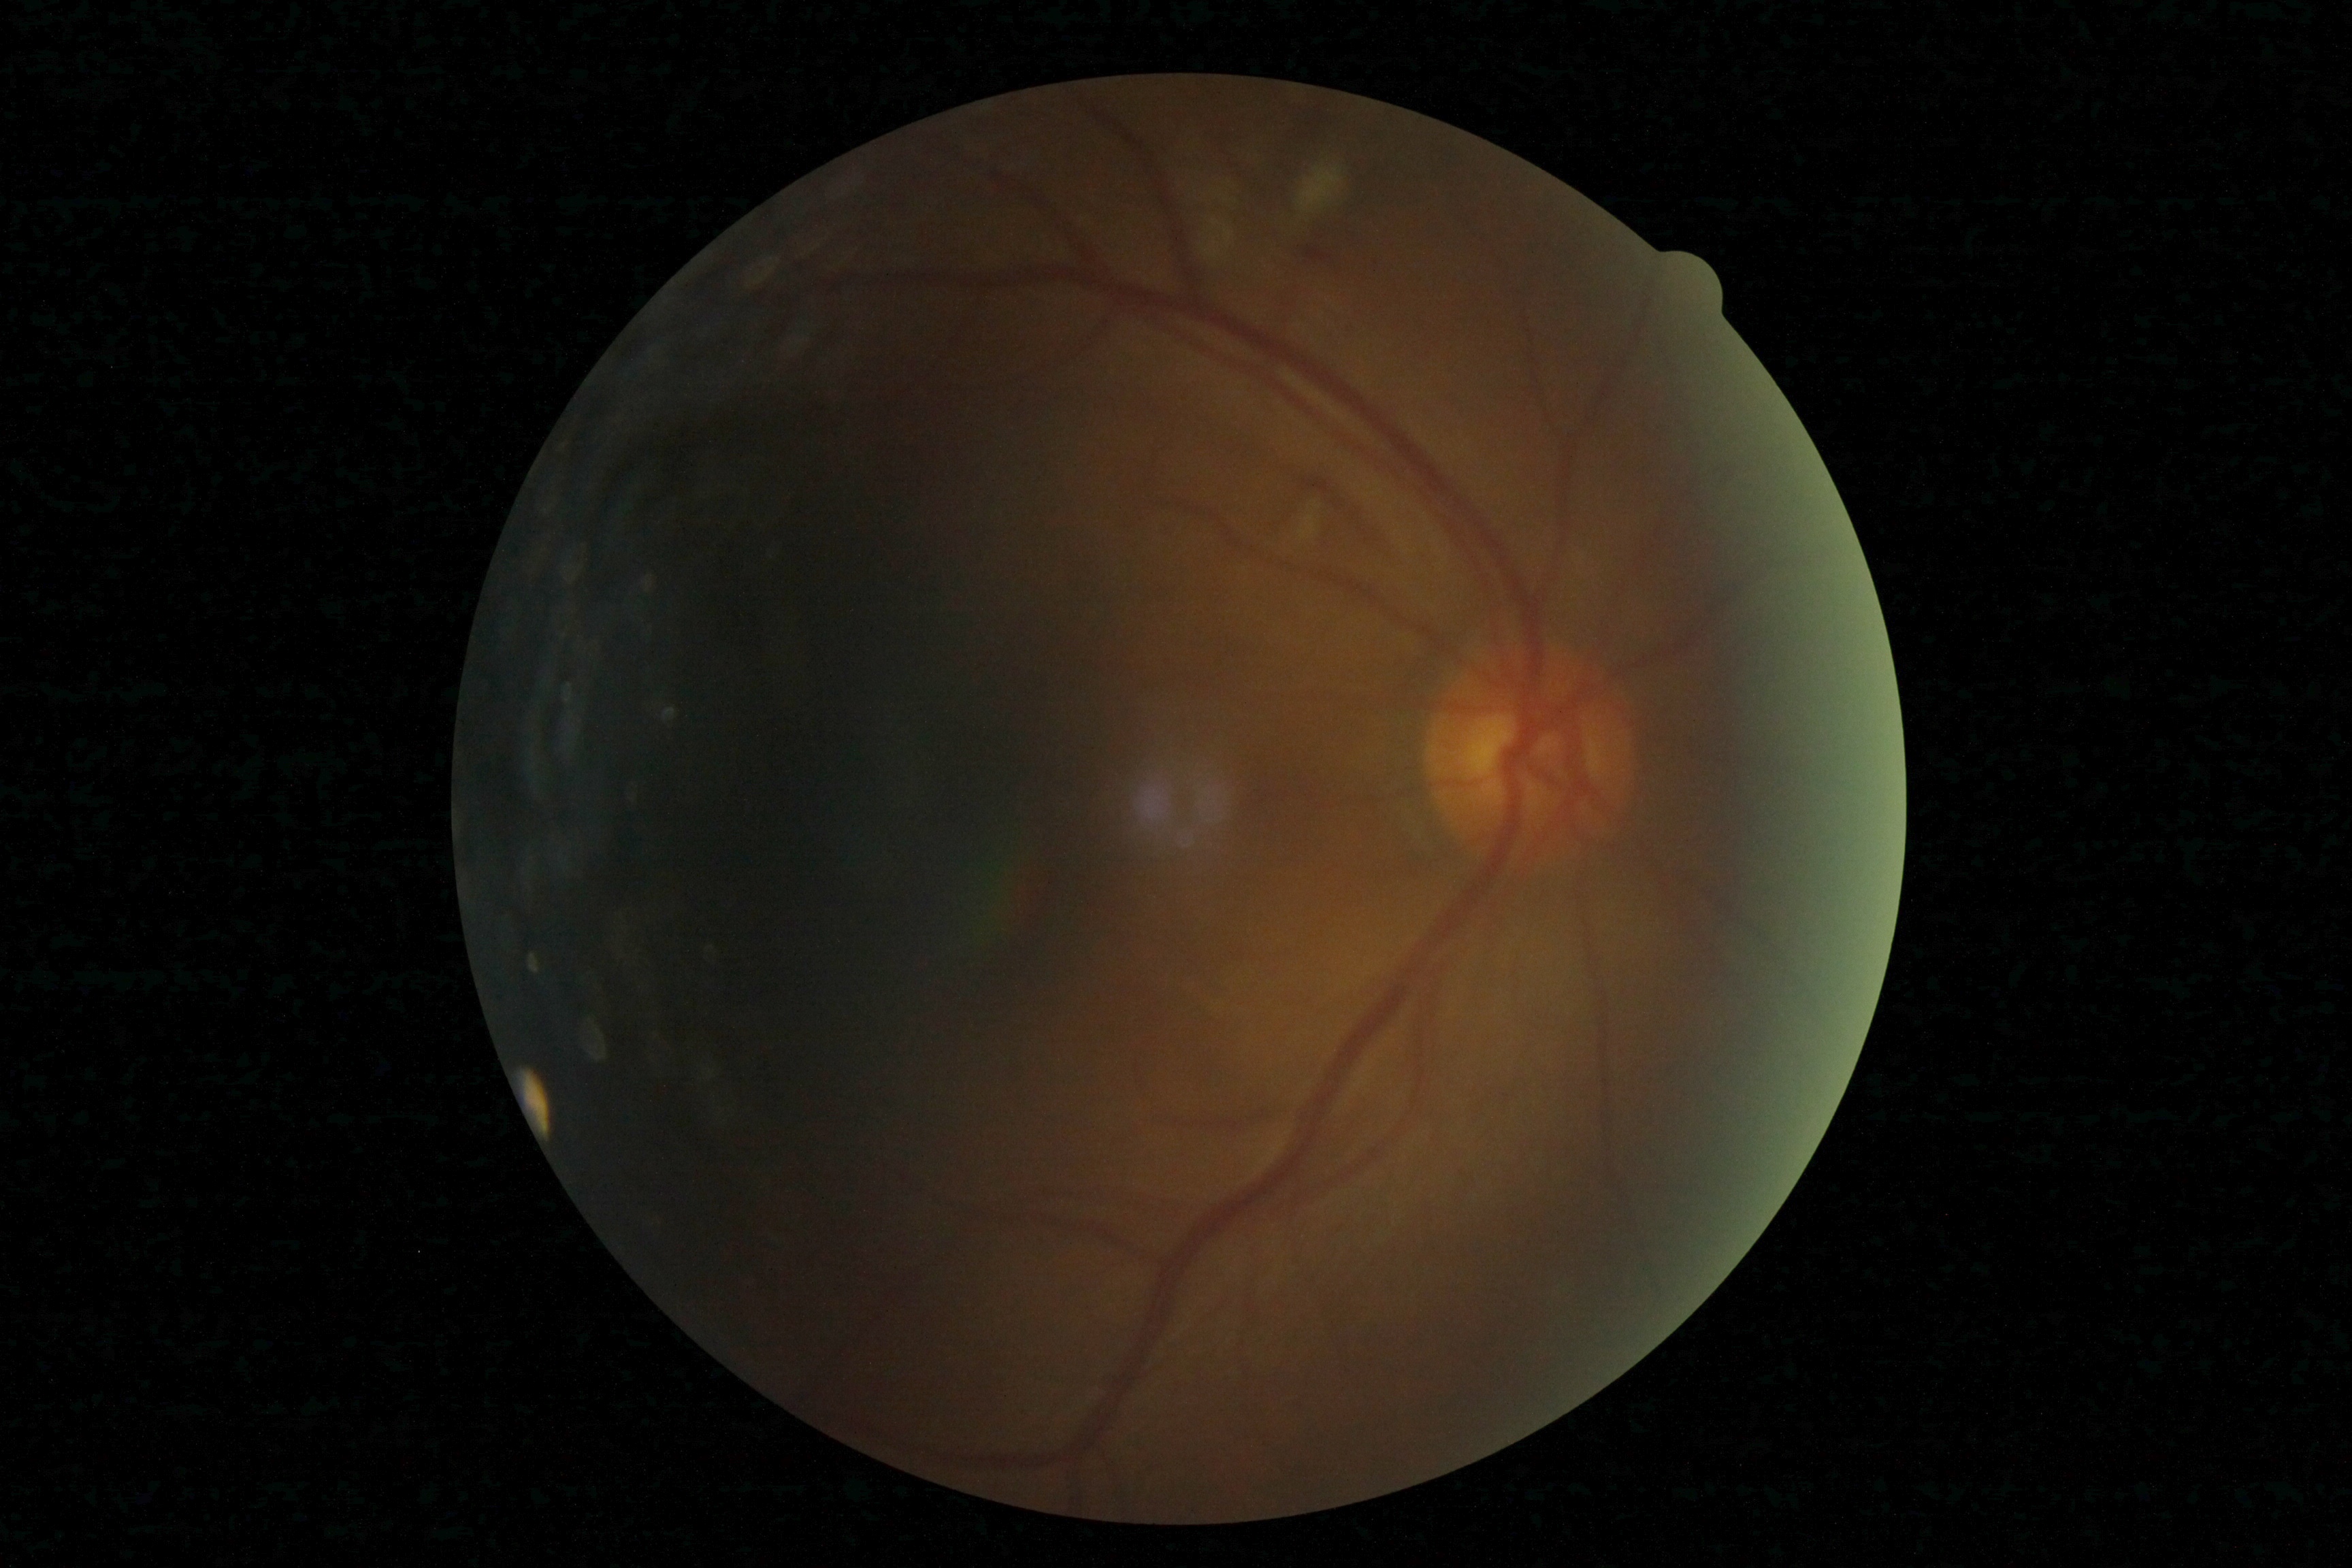

DR class: non-proliferative diabetic retinopathy
diabetic retinopathy severity: moderate non-proliferative diabetic retinopathy (grade 2)